45-degree field of view — 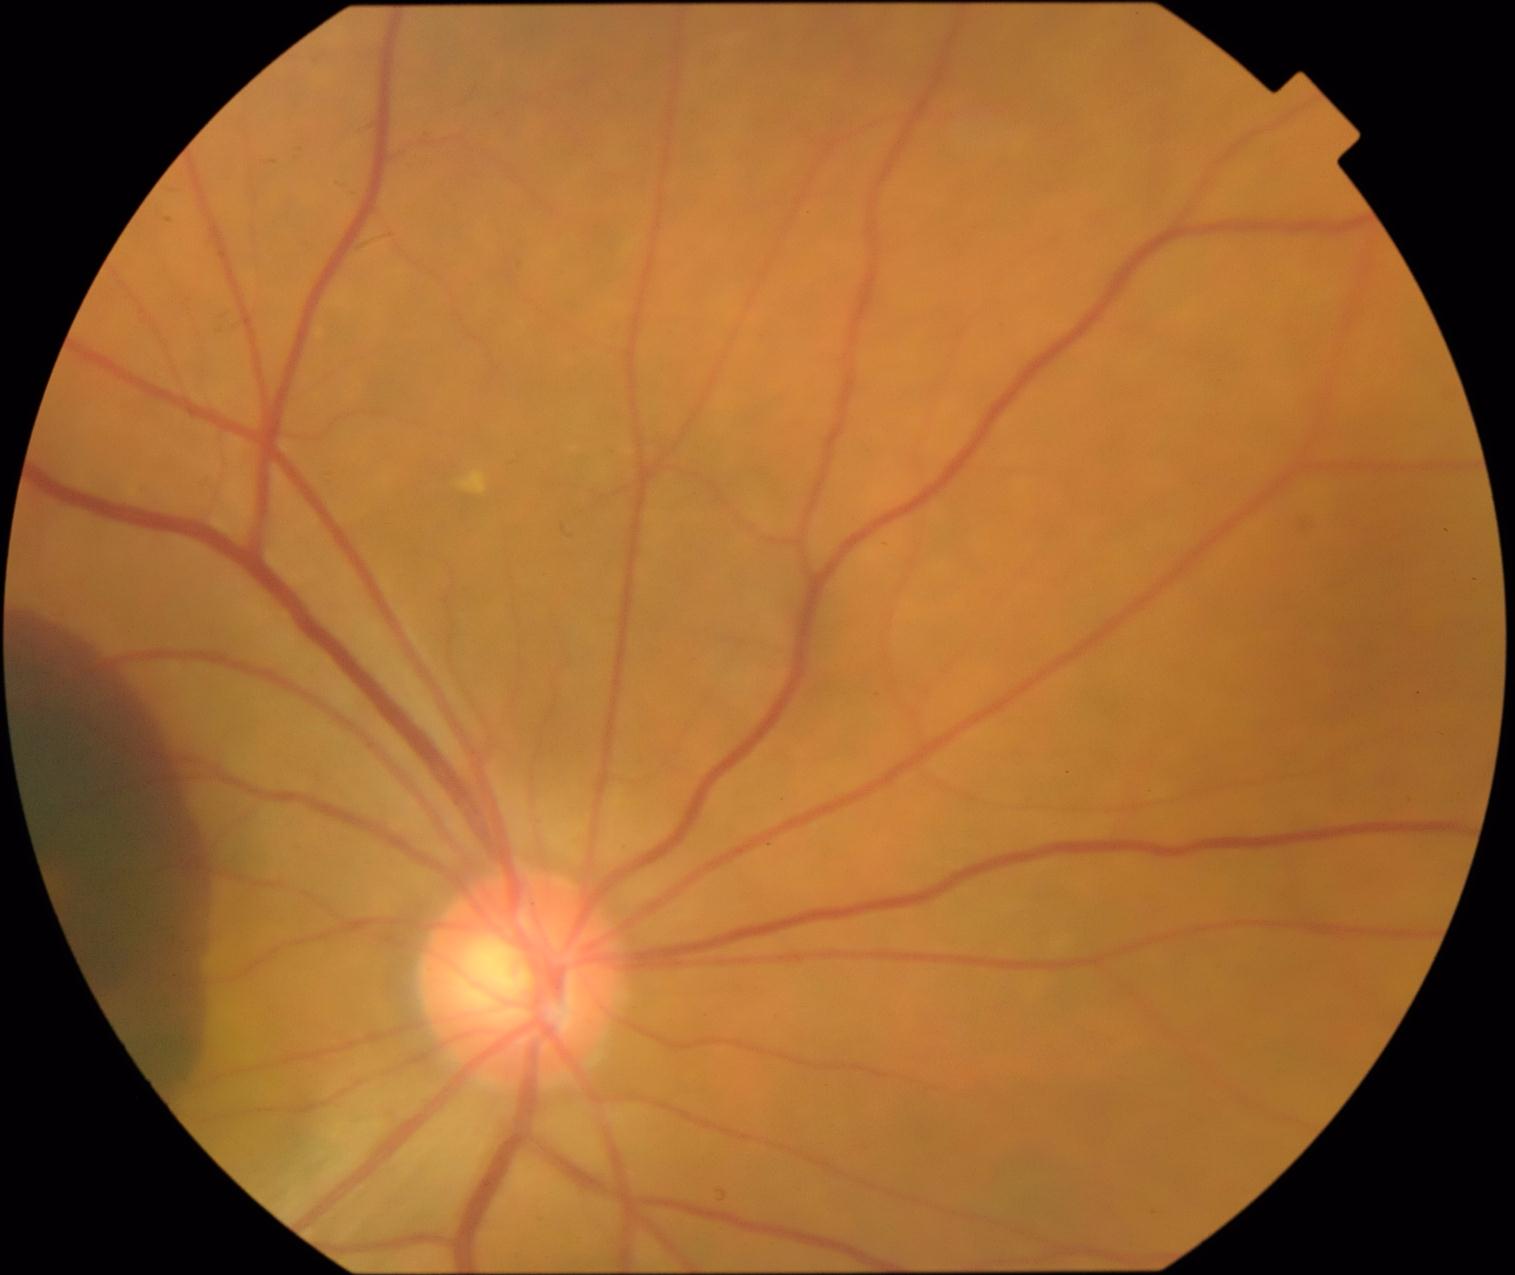

Retinopathy is PDR (grade 4) — neovascularization and/or vitreous/pre-retinal hemorrhage.